RetCam wide-field infant fundus image; 640 x 480 pixels:
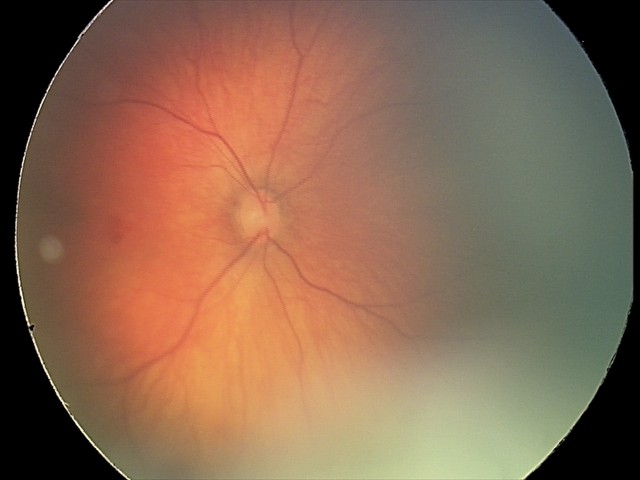 Series diagnosed as retinal hemorrhages.